45-degree field of view. 2048 x 1536 pixels.
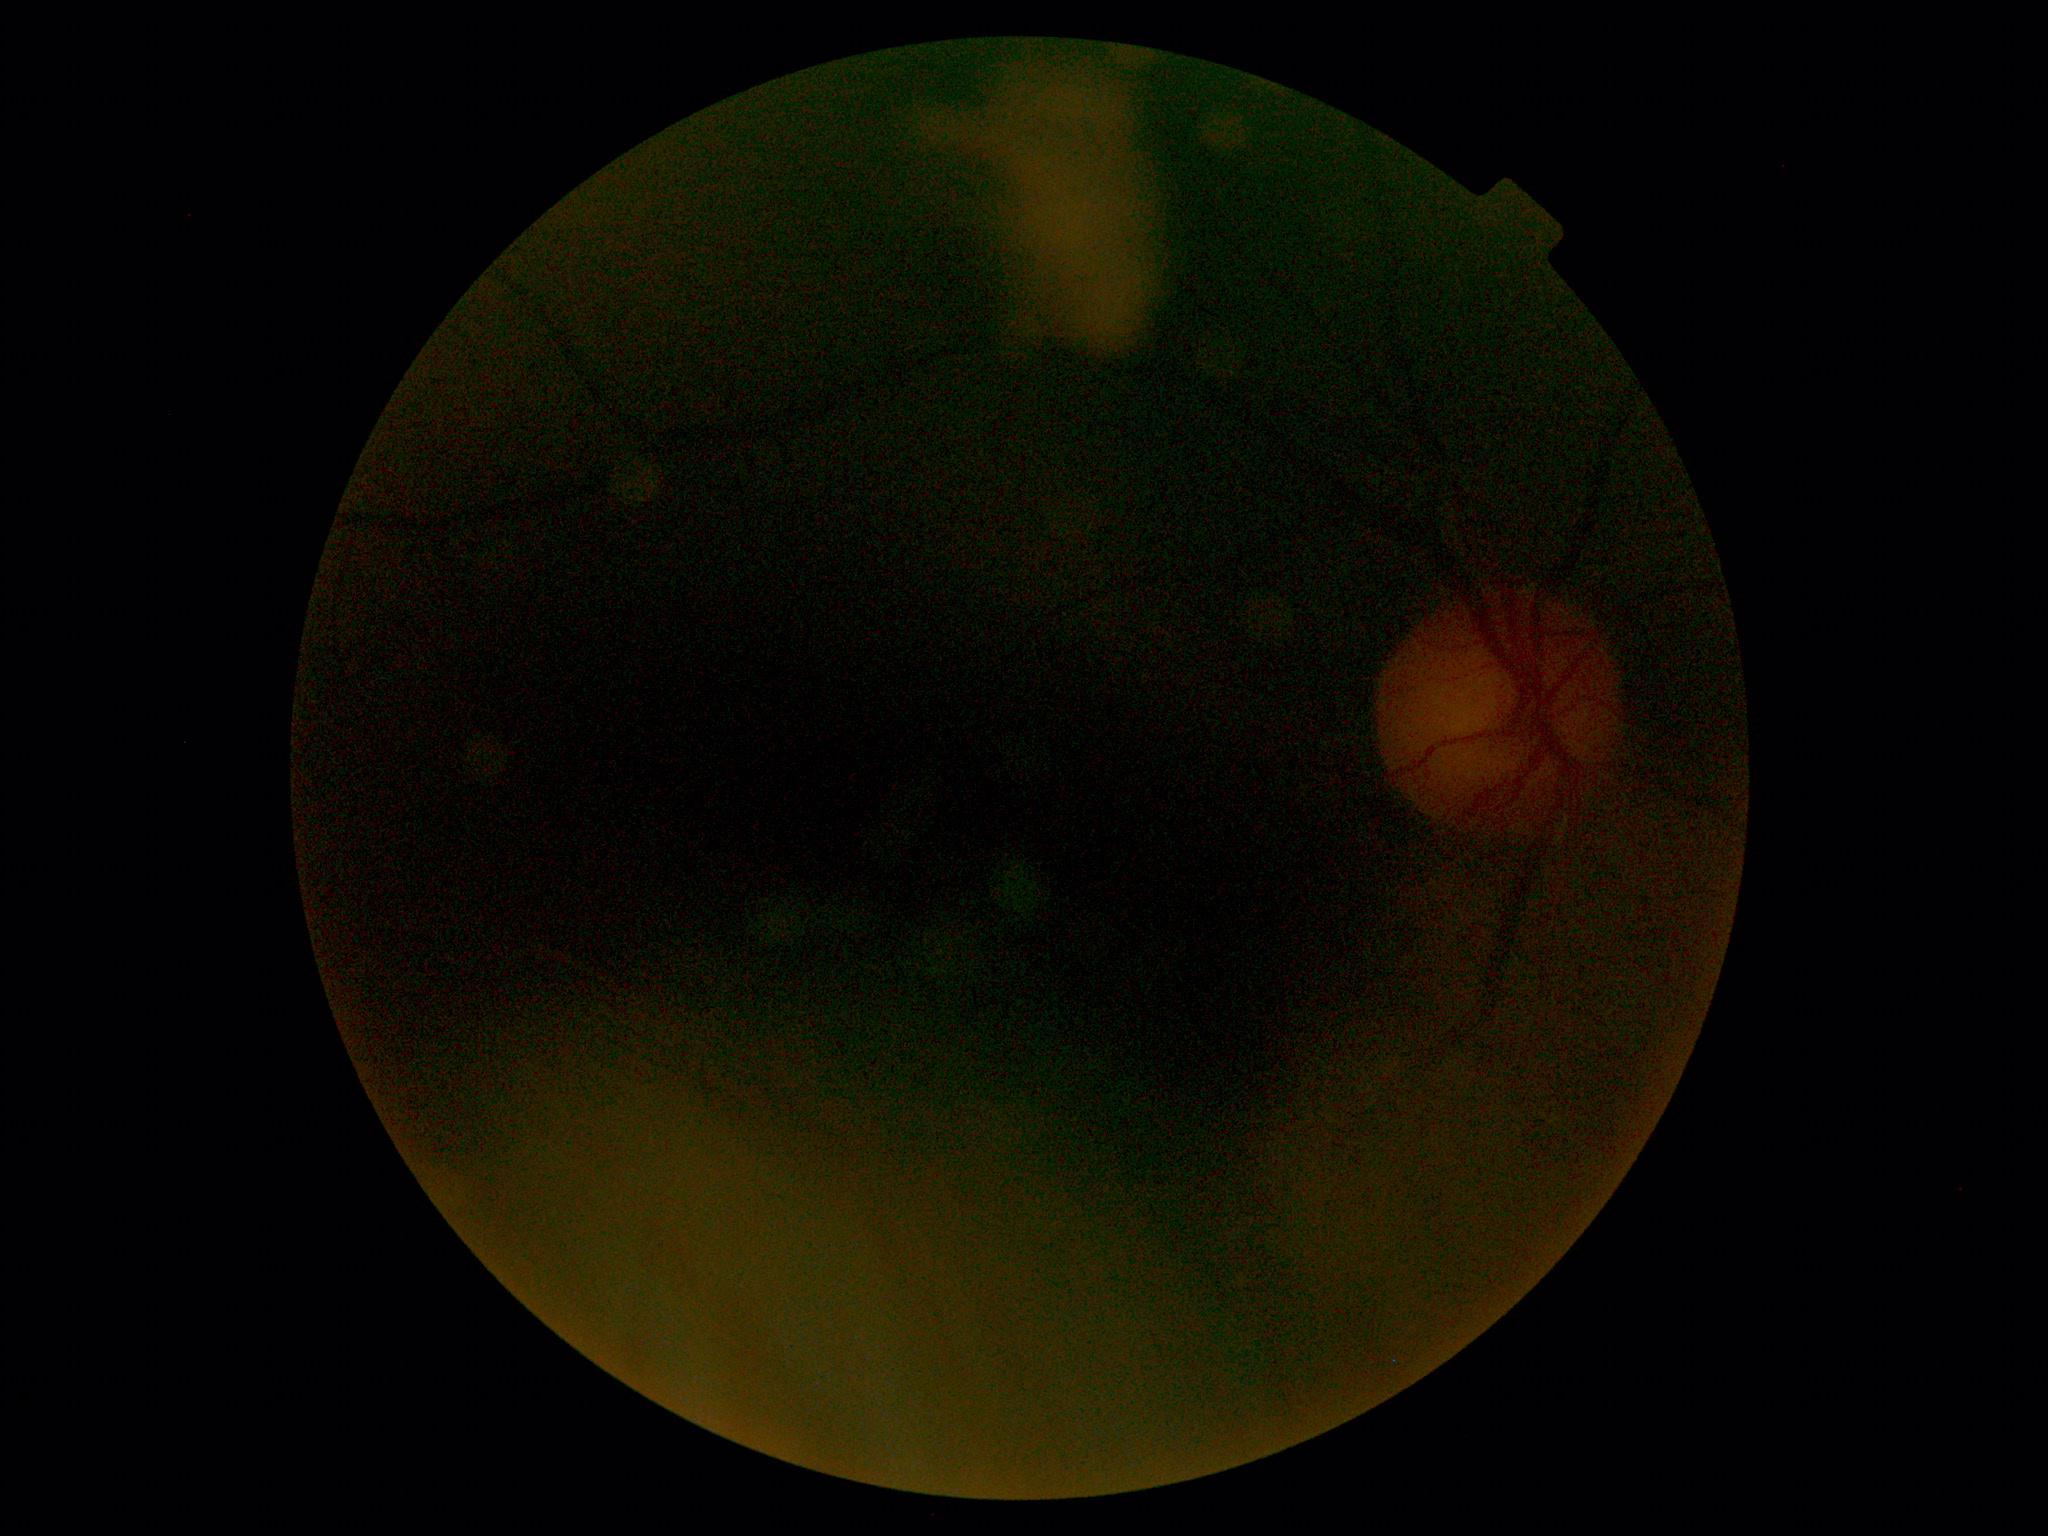 Diabetic retinopathy is ungradable due to poor image quality.
Quality too poor to assess for DR.